Posterior pole photograph. DR severity per modified Davis staging. NIDEK AFC-230 fundus camera — 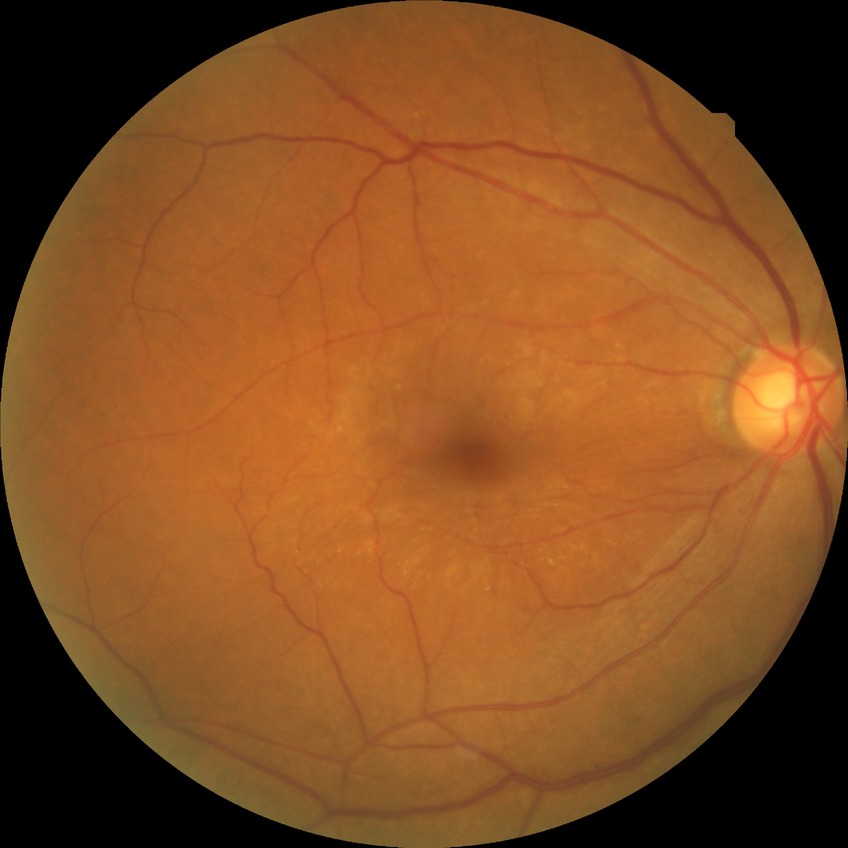

davis_grade: PPDR (pre-proliferative diabetic retinopathy)